FOV: 45 degrees:
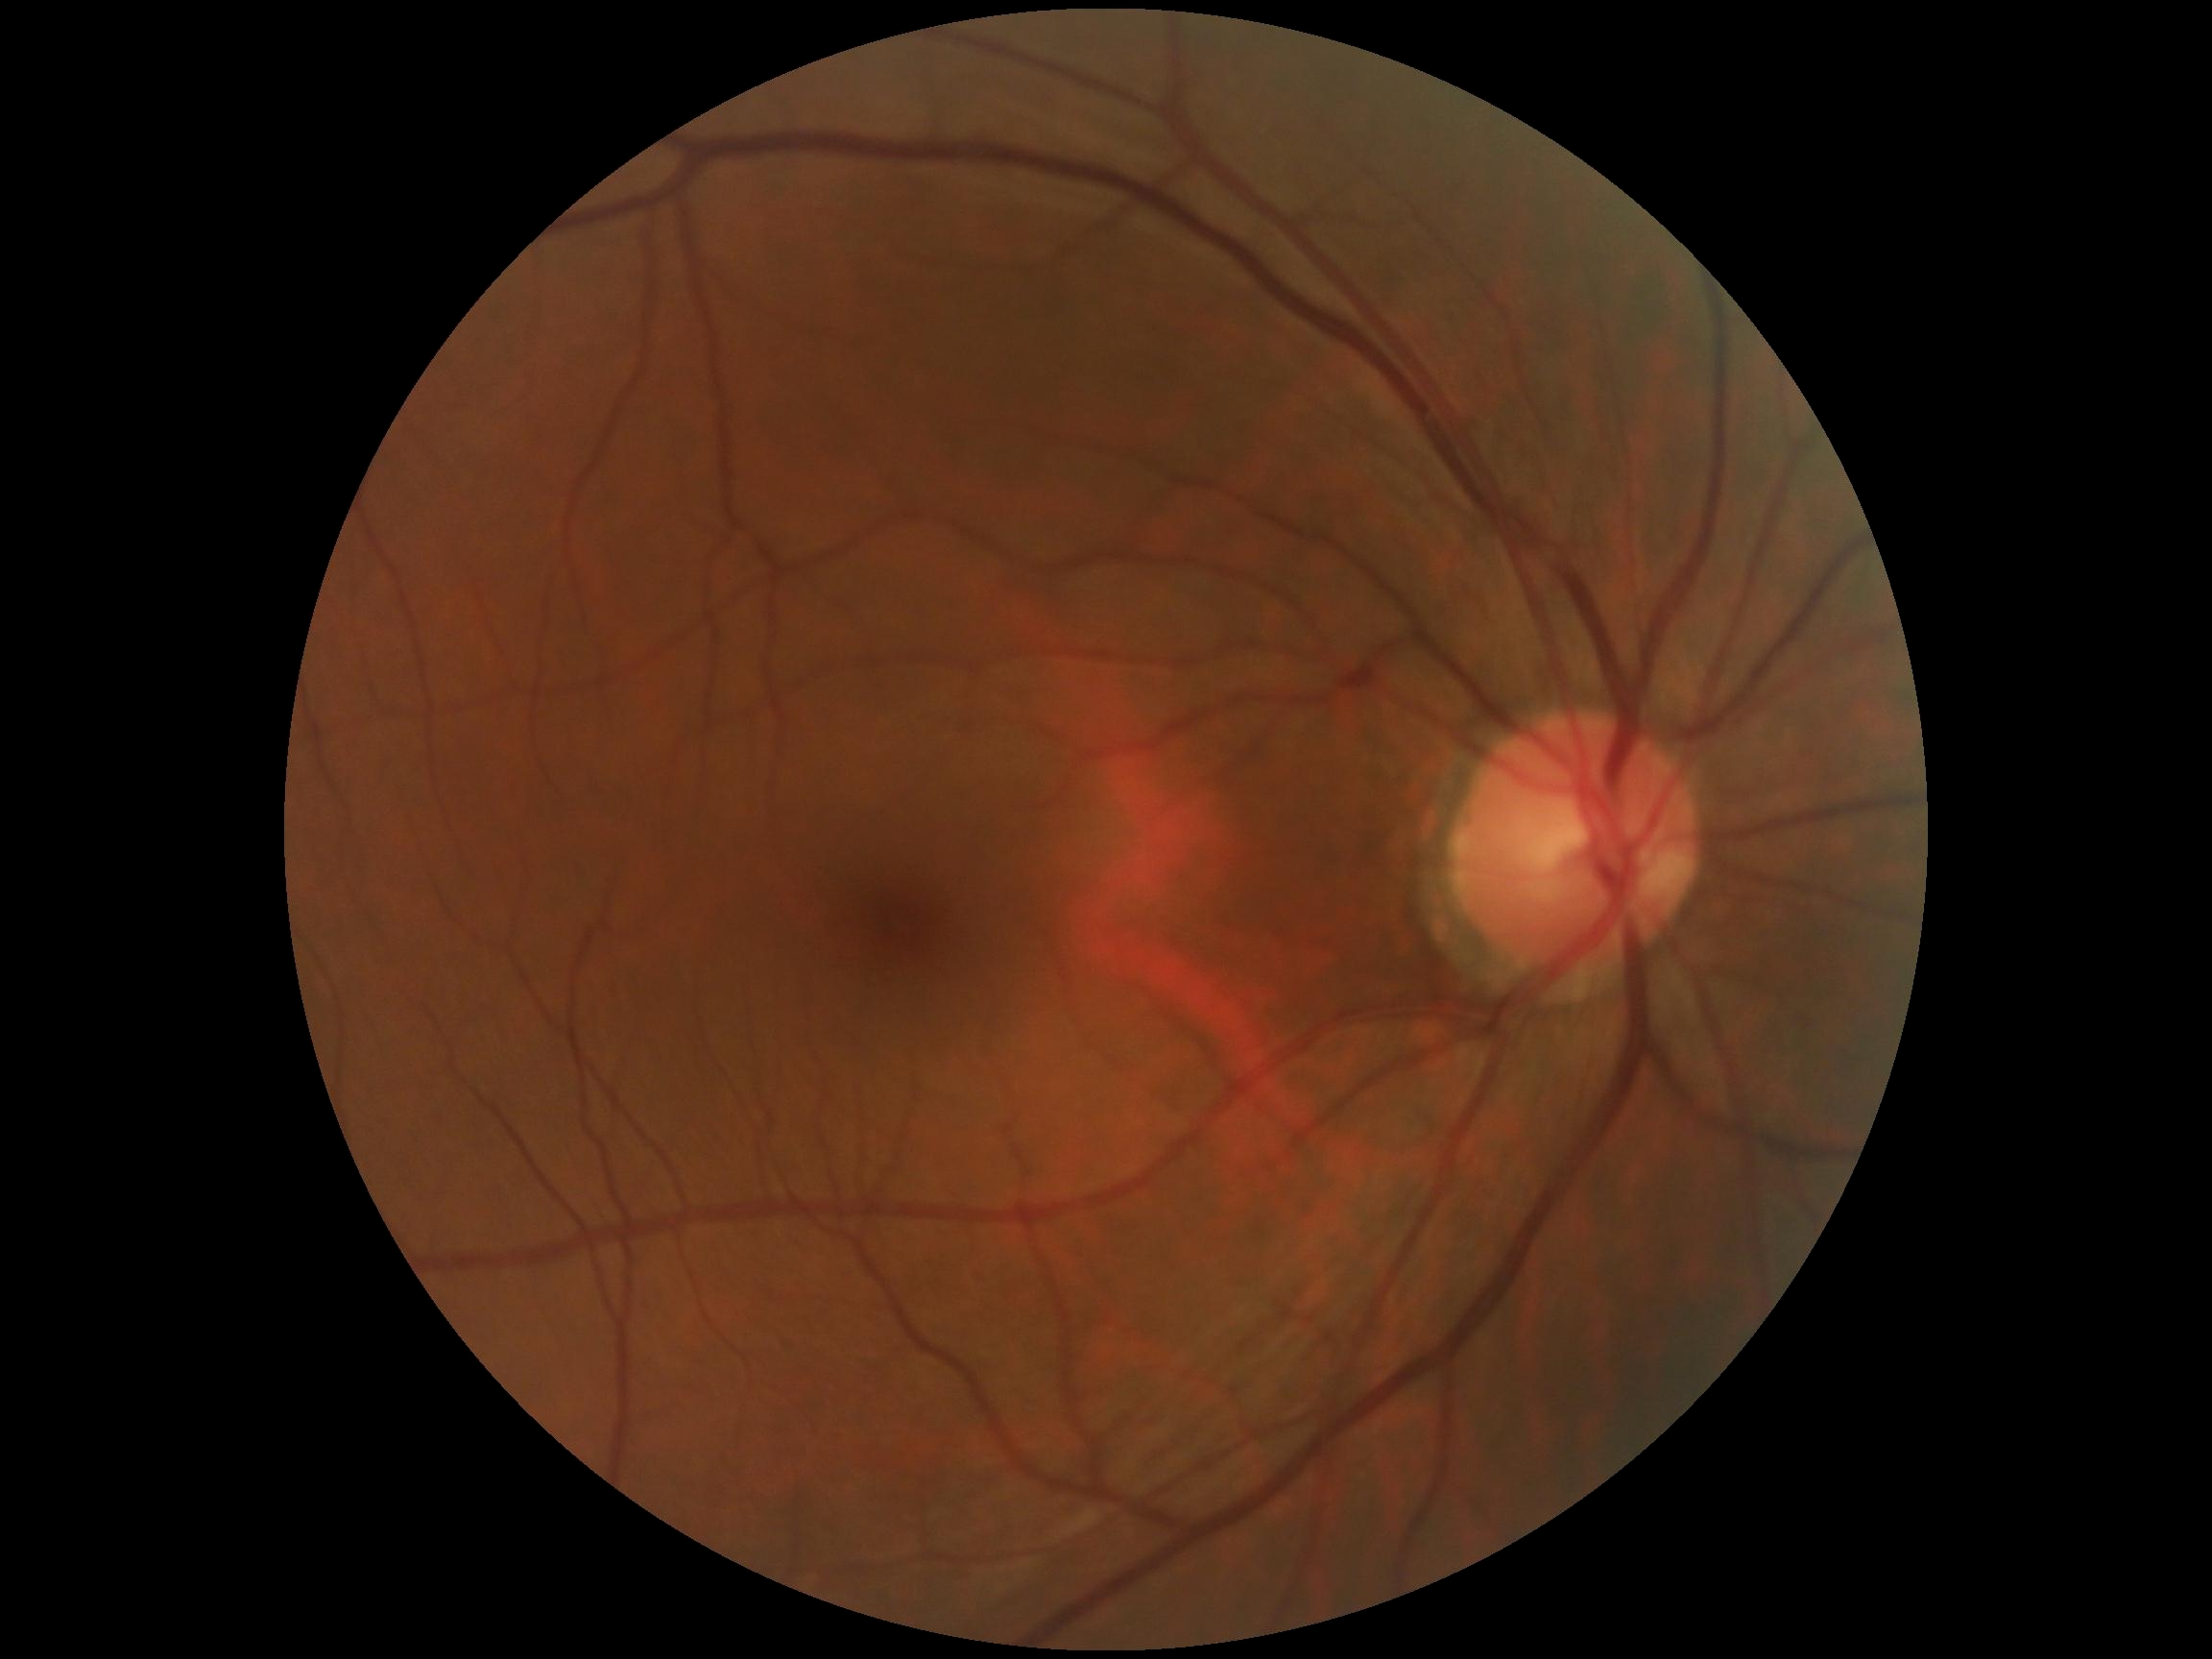 No DR findings. Diabetic retinopathy grade is 0.